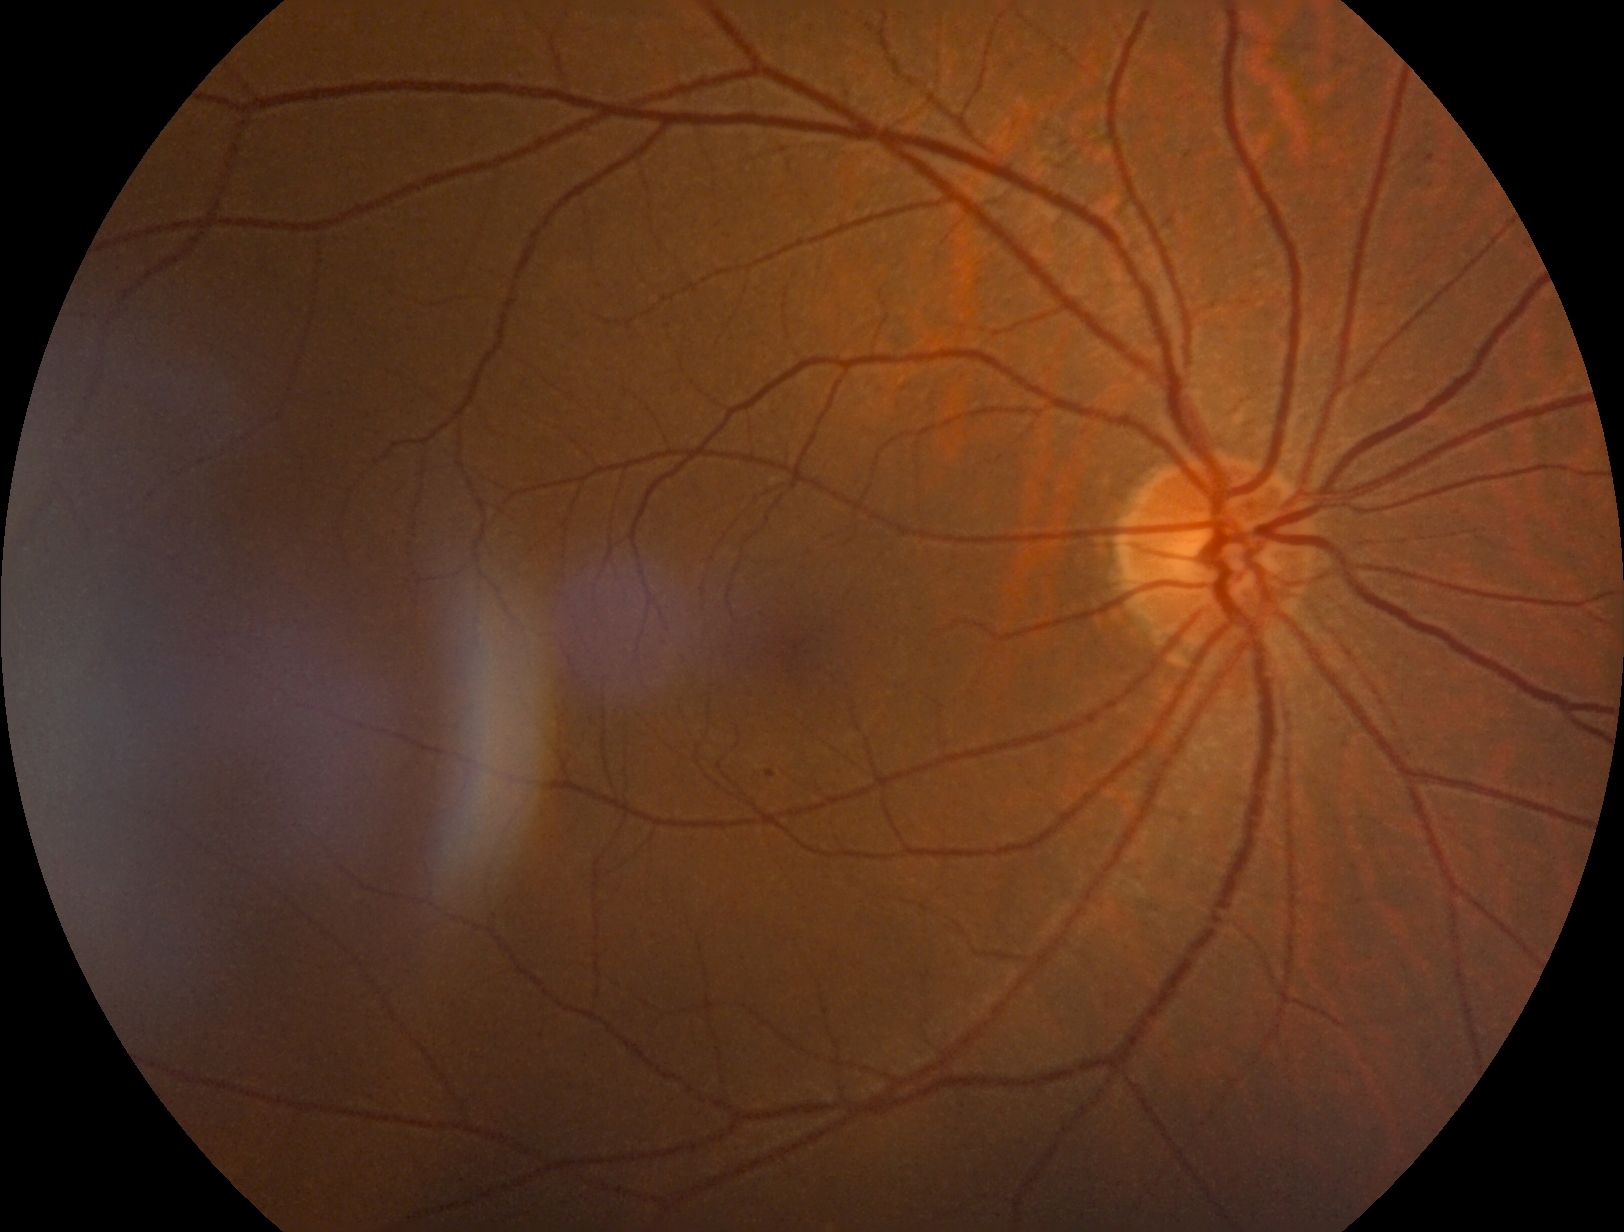 Diabetic retinopathy grade: mild non-proliferative diabetic retinopathy (1); non-proliferative diabetic retinopathy
Lesions:
* hard exudates: none detected
* microaneurysms: 766,771,775,779
* Microaneurysms (small, approximate centers) near (x=1346, y=747)
* soft exudates: none detected
* hemorrhages: none detected